50° field of view
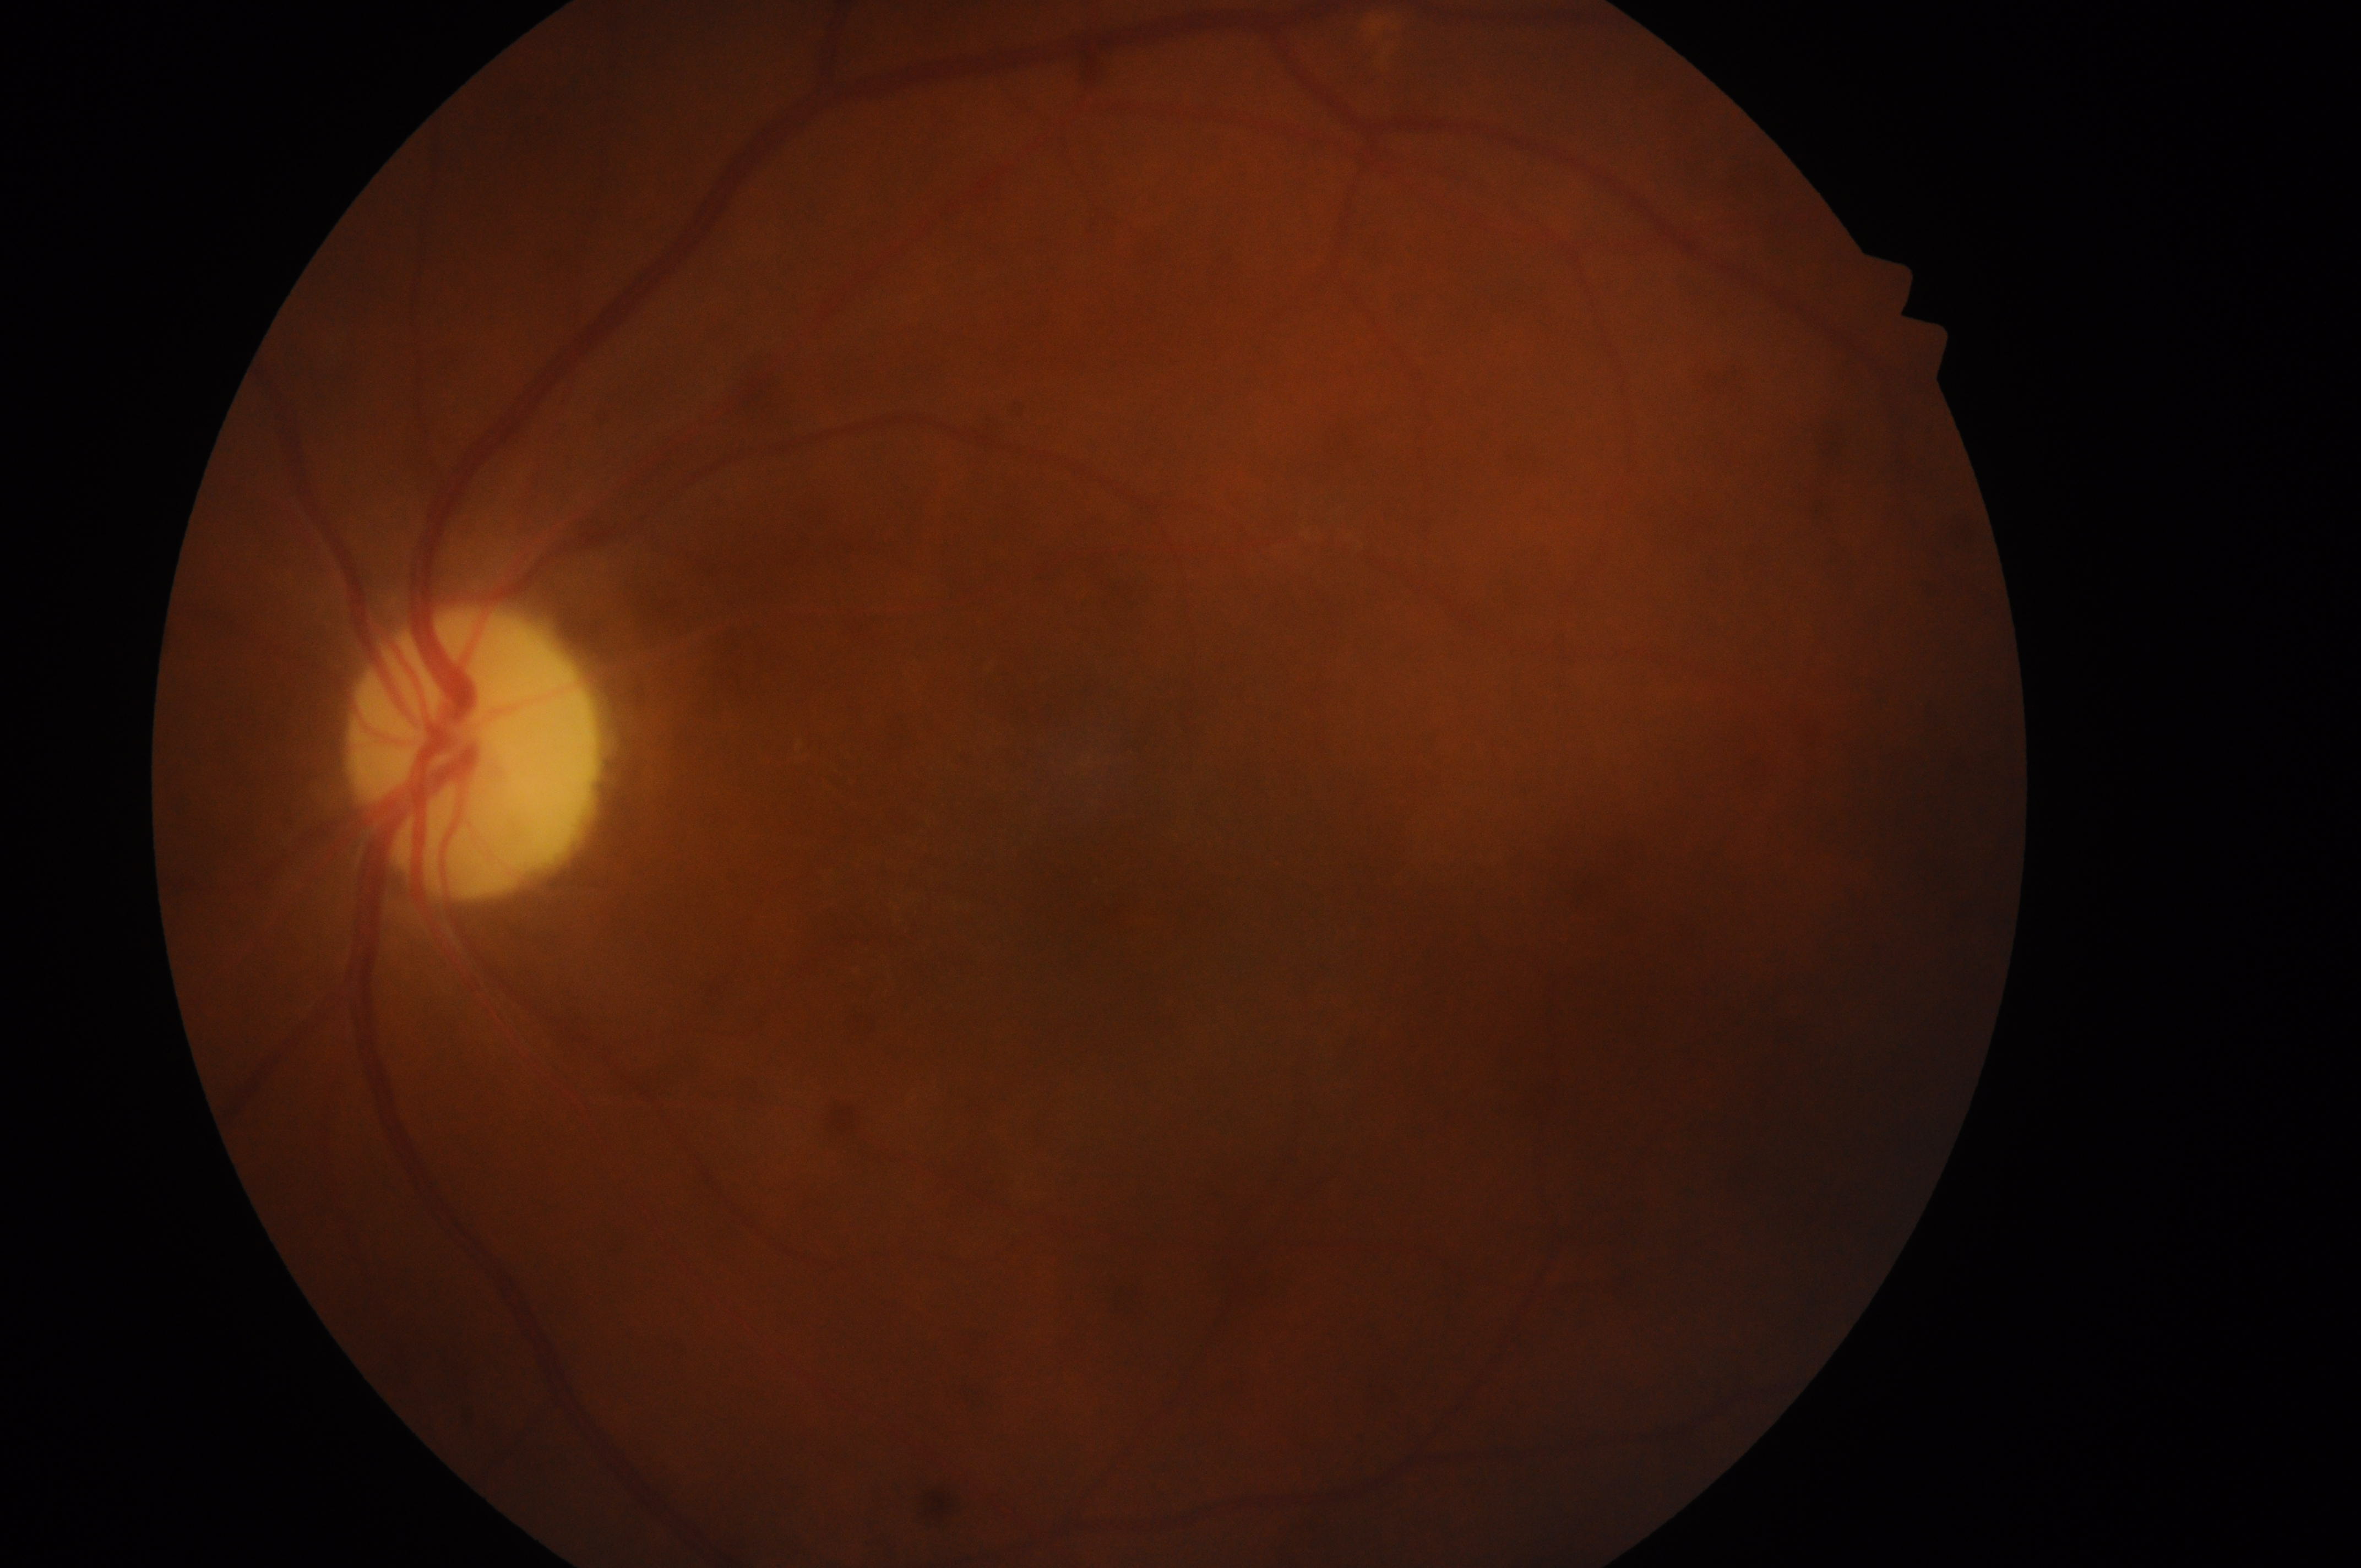 the left eye
ONH@(472,763)
DR grade@0 (no apparent retinopathy)
DME@grade 0 (no risk)
No DR or DME findings
fovea centralis@(1140,903)